2212 x 1661 pixels · autorefraction: +0.75 -0.25 × 49° · gender: F · intraocular pressure (IOP) by non-contact tonometry: 14 mmHg · central corneal thickness: 537 µm — 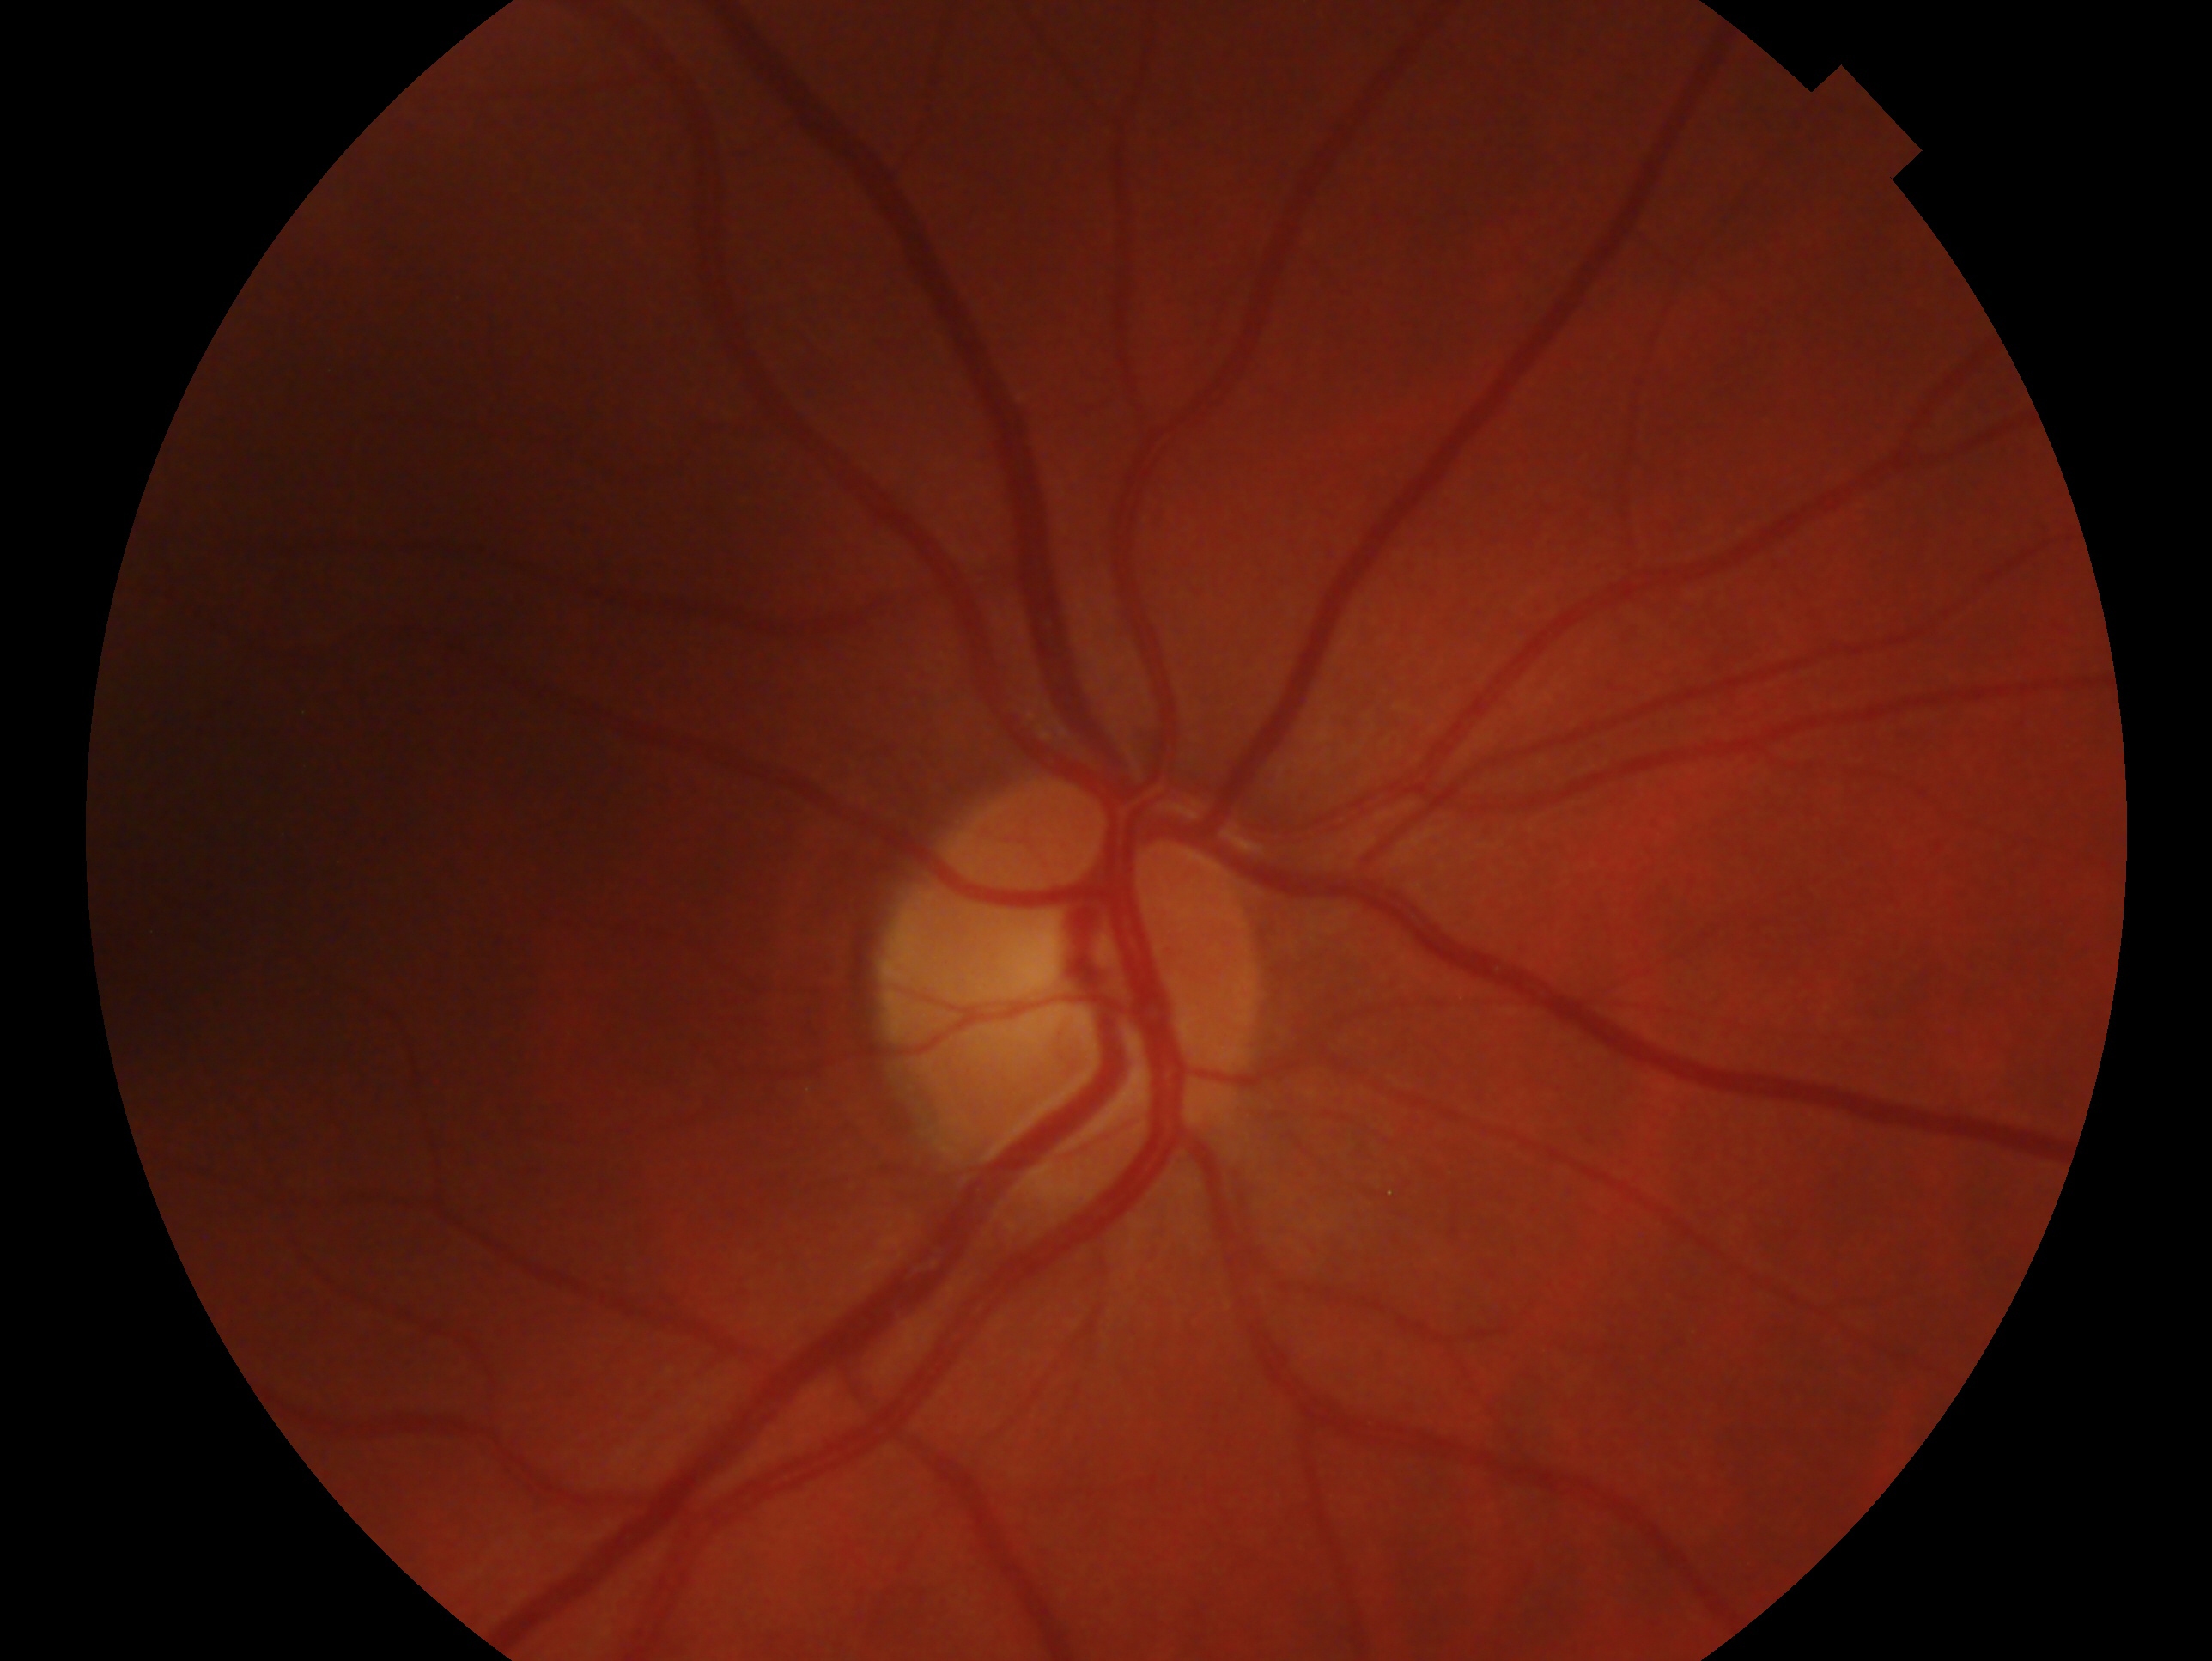

  eye: right
  glaucoma_dx: no evidence of glaucoma — no clinical evidence of glaucoma in this eye